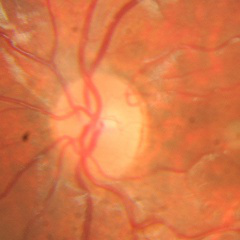 Glaucoma stage = no evidence of glaucoma.